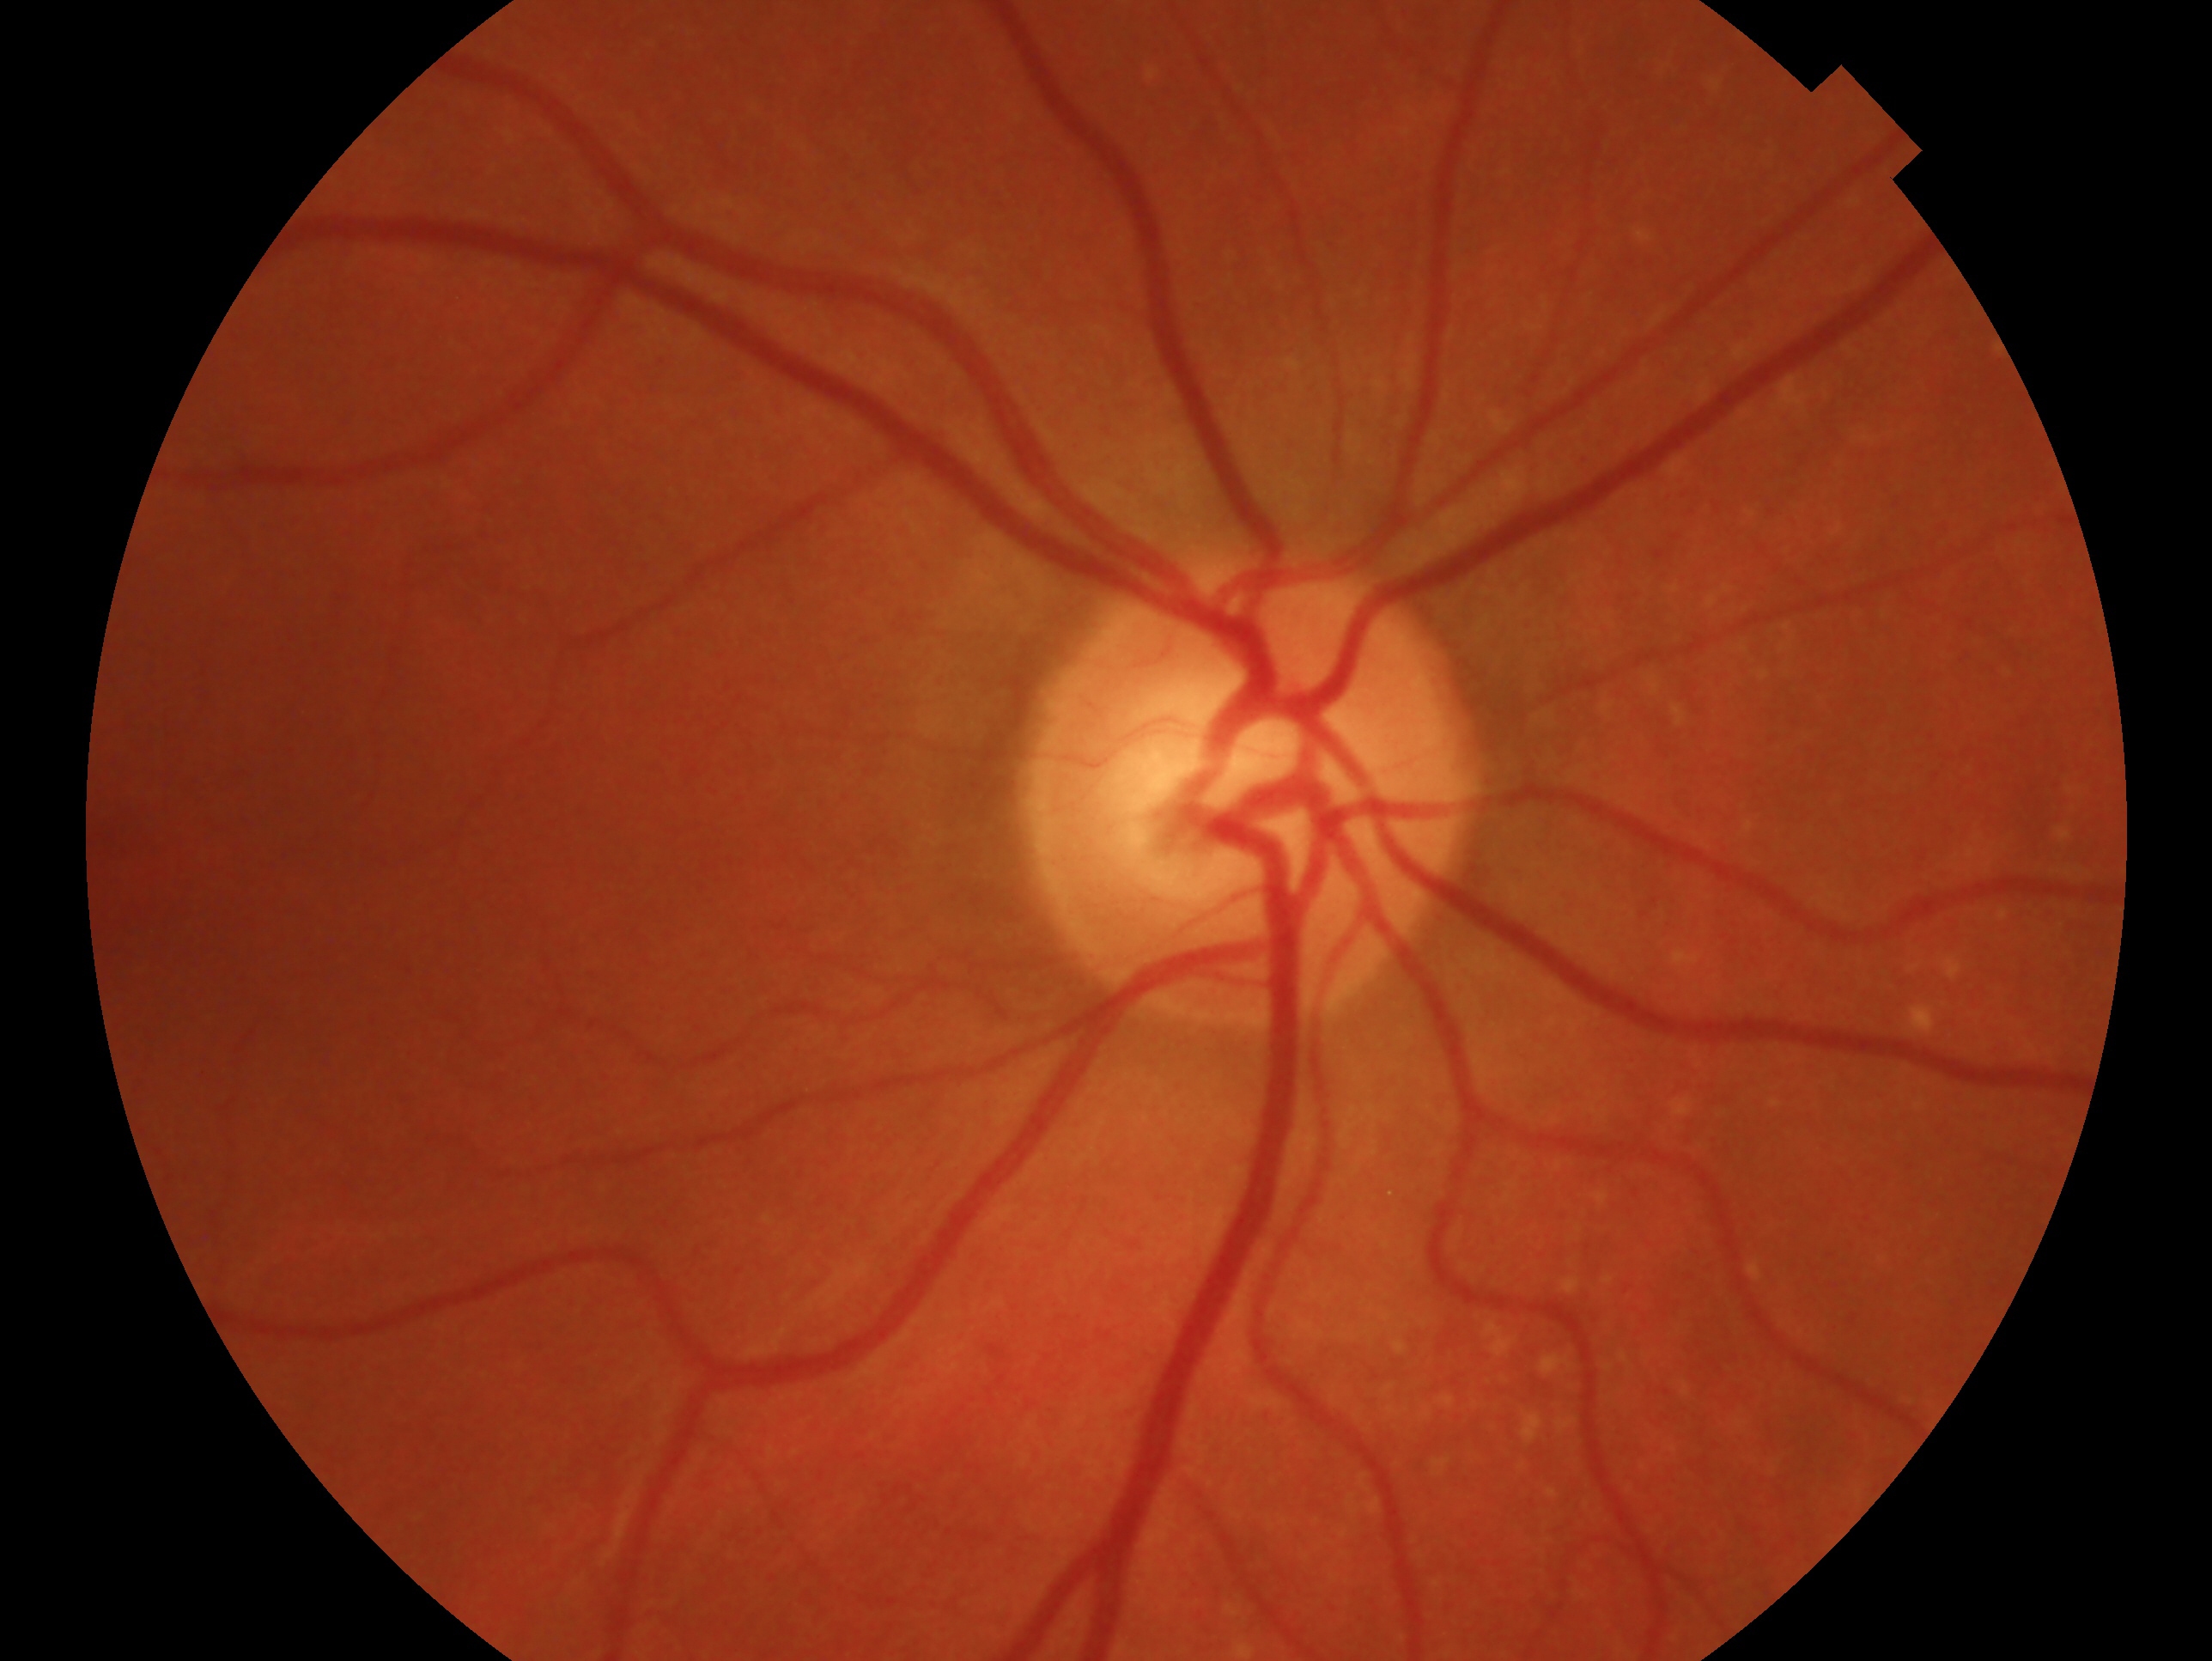 Assessment: no glaucoma.
Eye: right eye.